45-degree field of view, image size 2352x1568
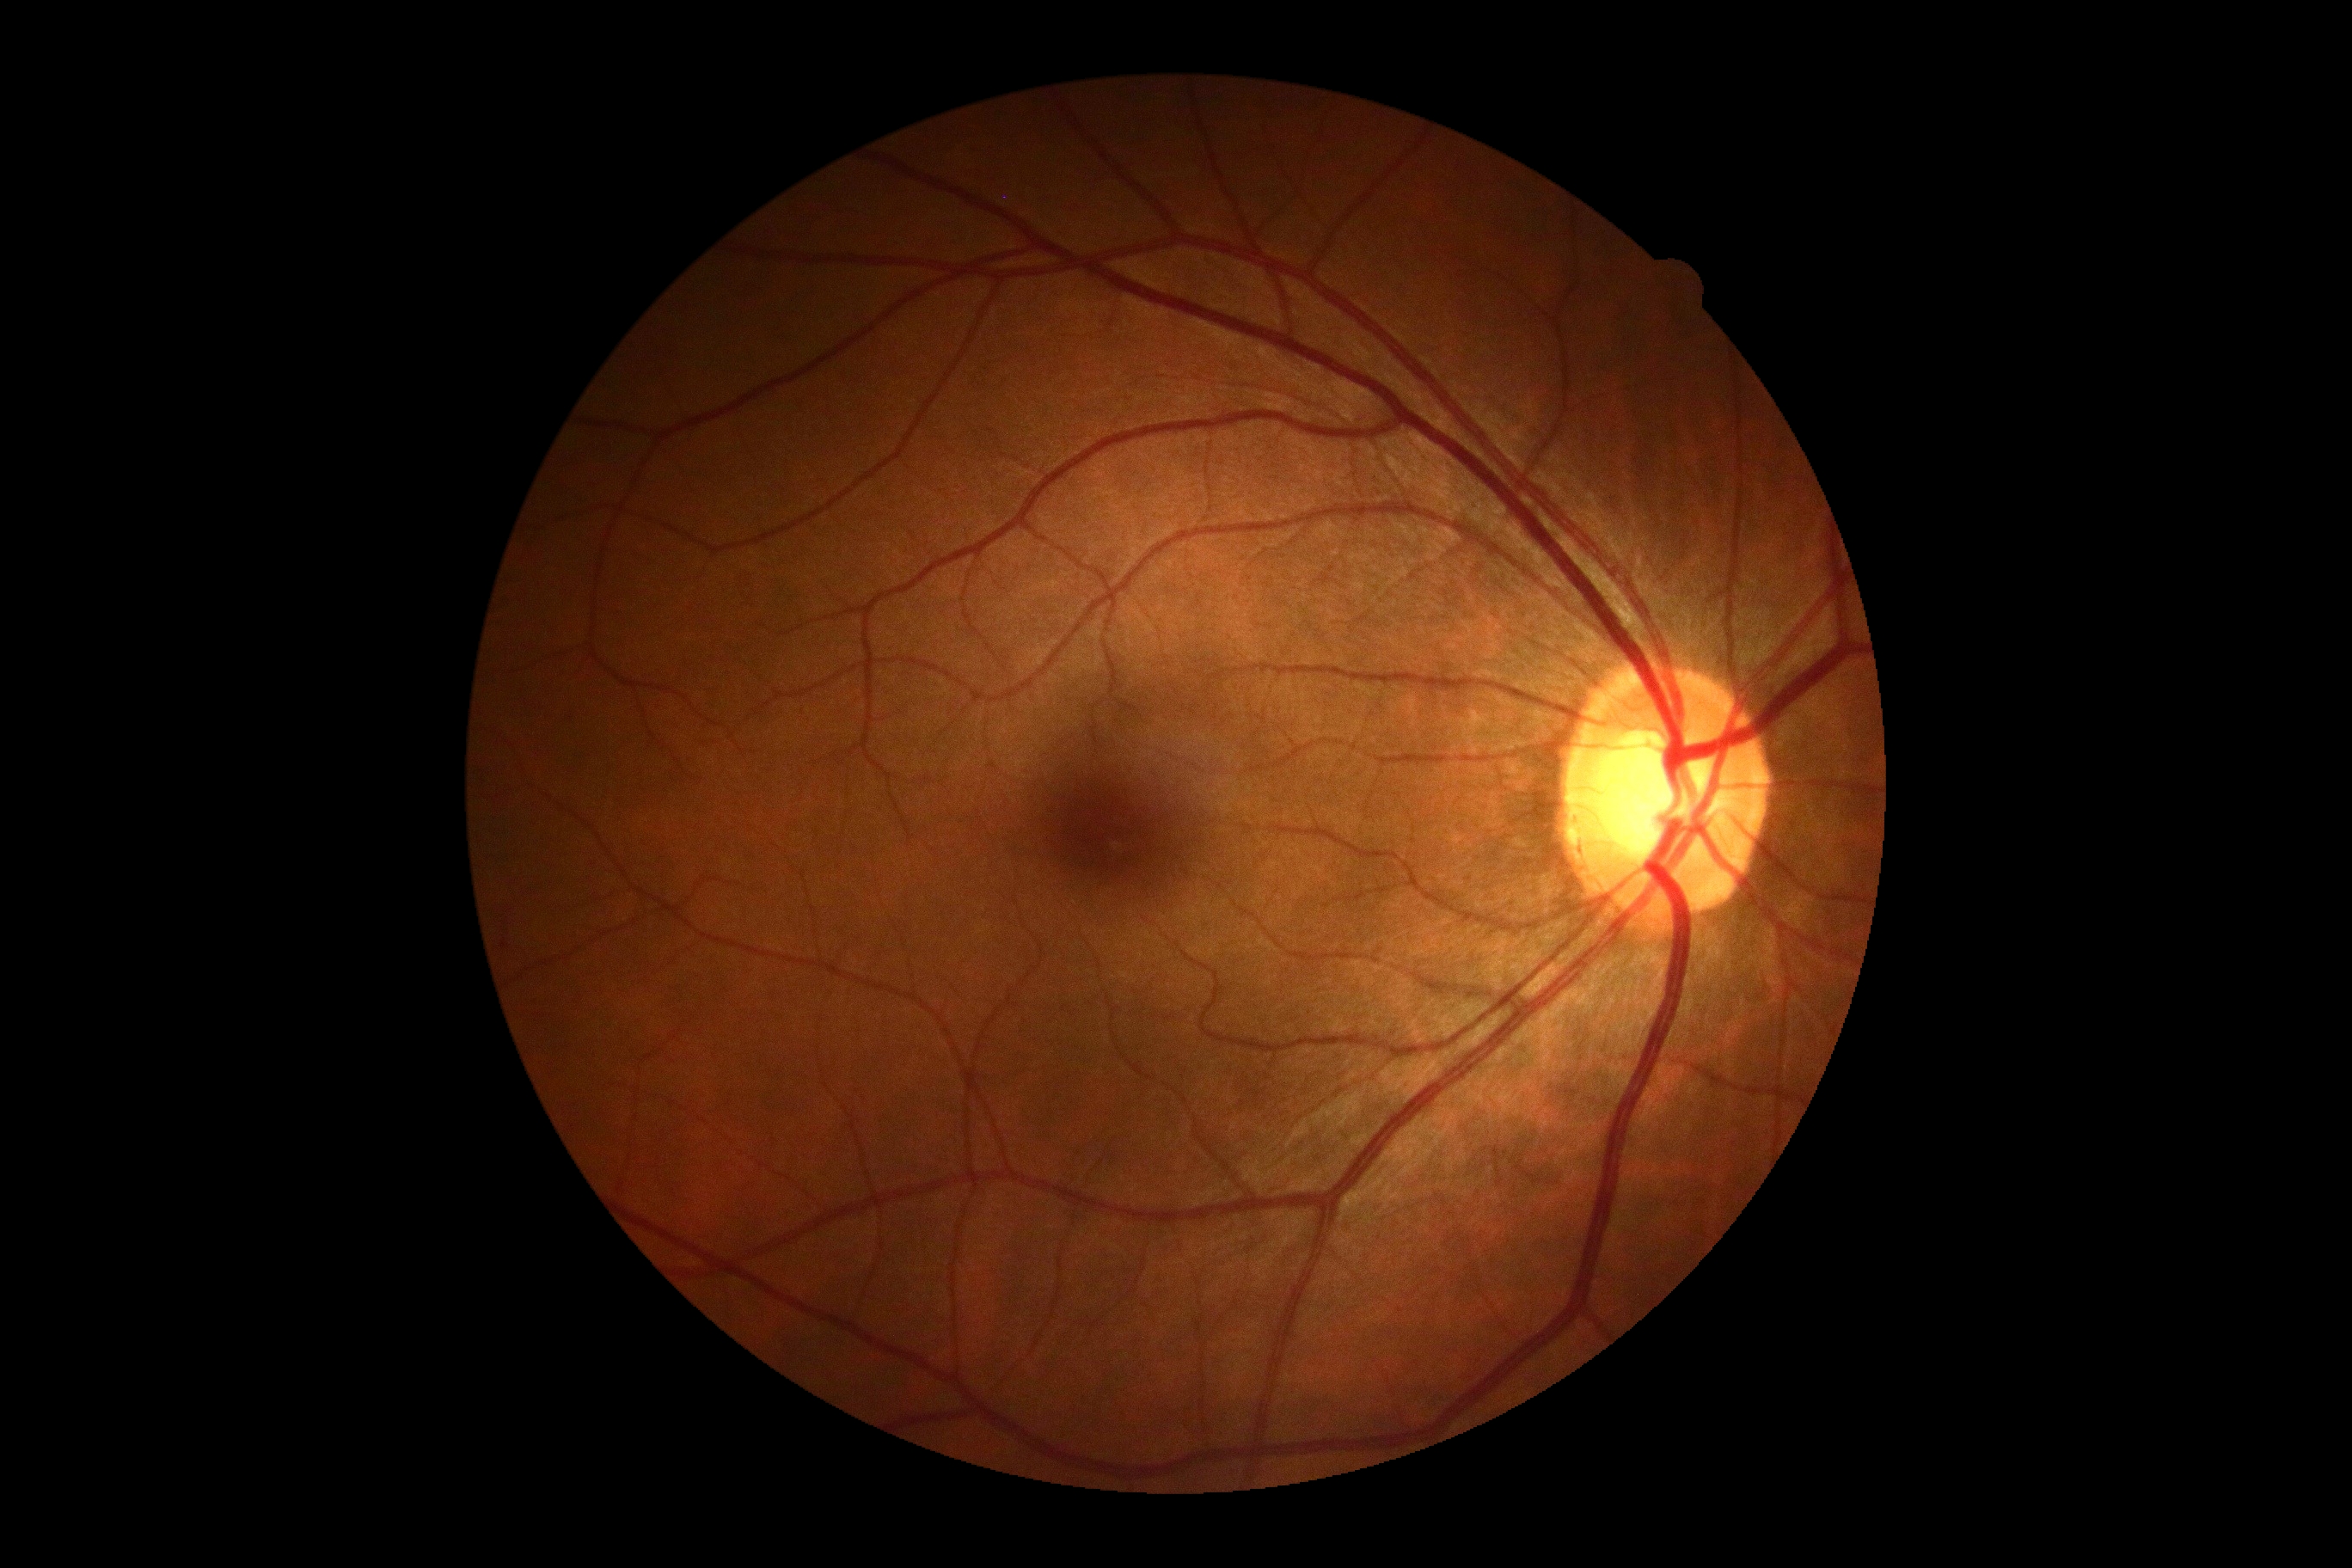

Findings:
- DR impression — no DR findings
- DR — no apparent diabetic retinopathy (grade 0) — no visible signs of diabetic retinopathy